Posterior pole photograph · graded on the modified Davis scale
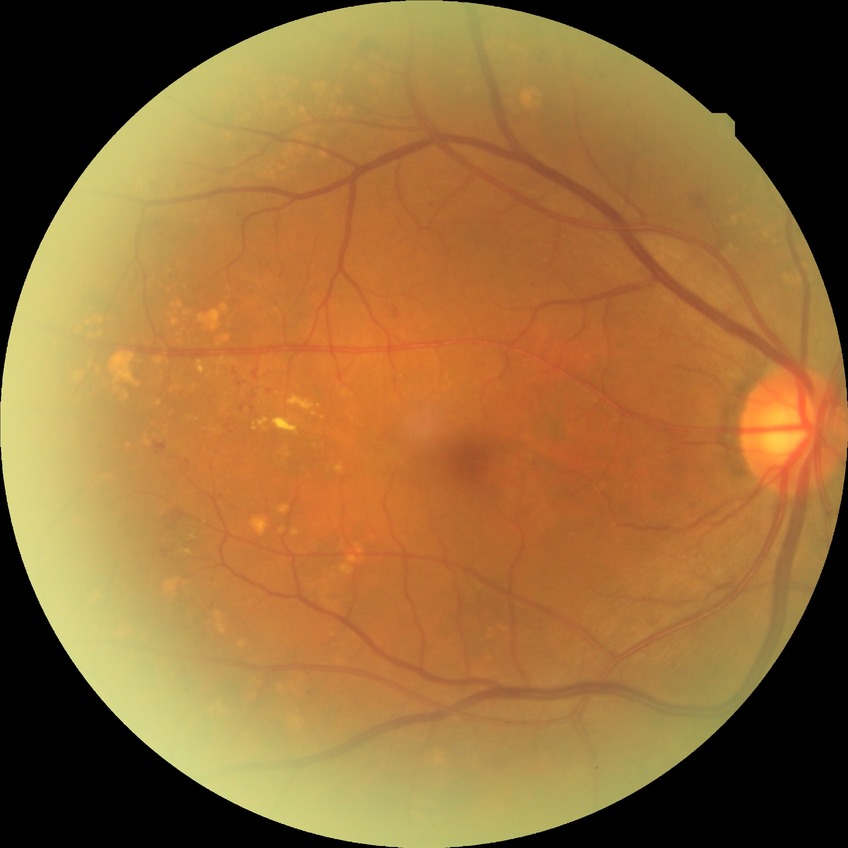 Diabetic retinopathy severity: pre-proliferative diabetic retinopathy.